Pediatric wide-field fundus photograph; 1240 x 1240 pixels
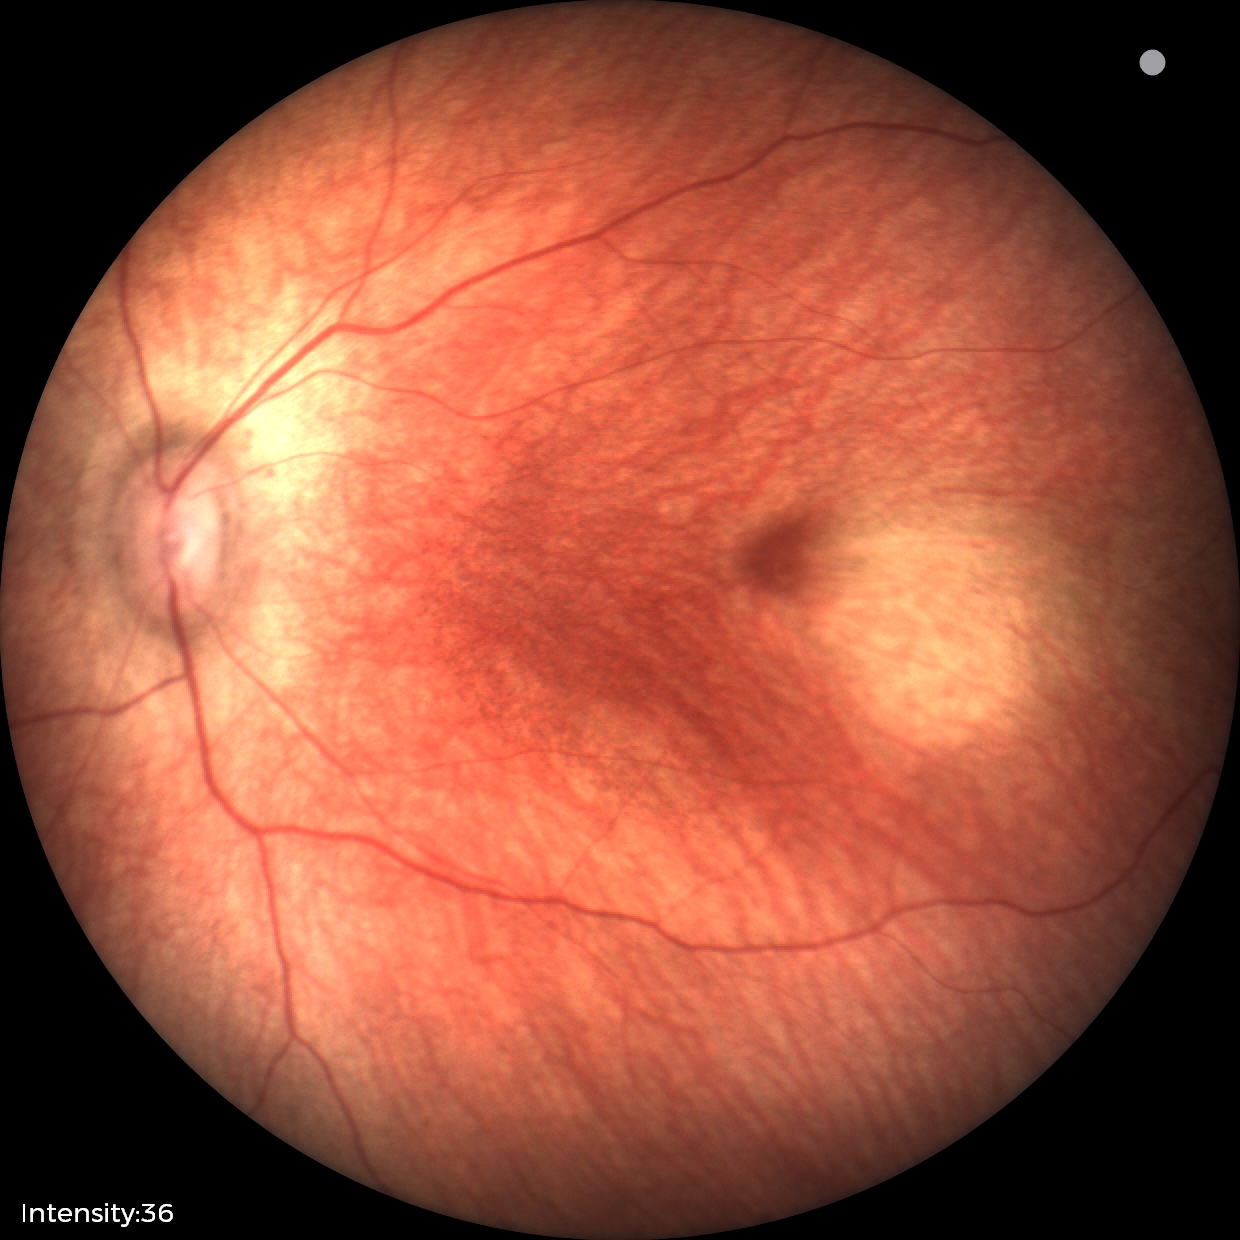

Assessment: no abnormal retinal findings.